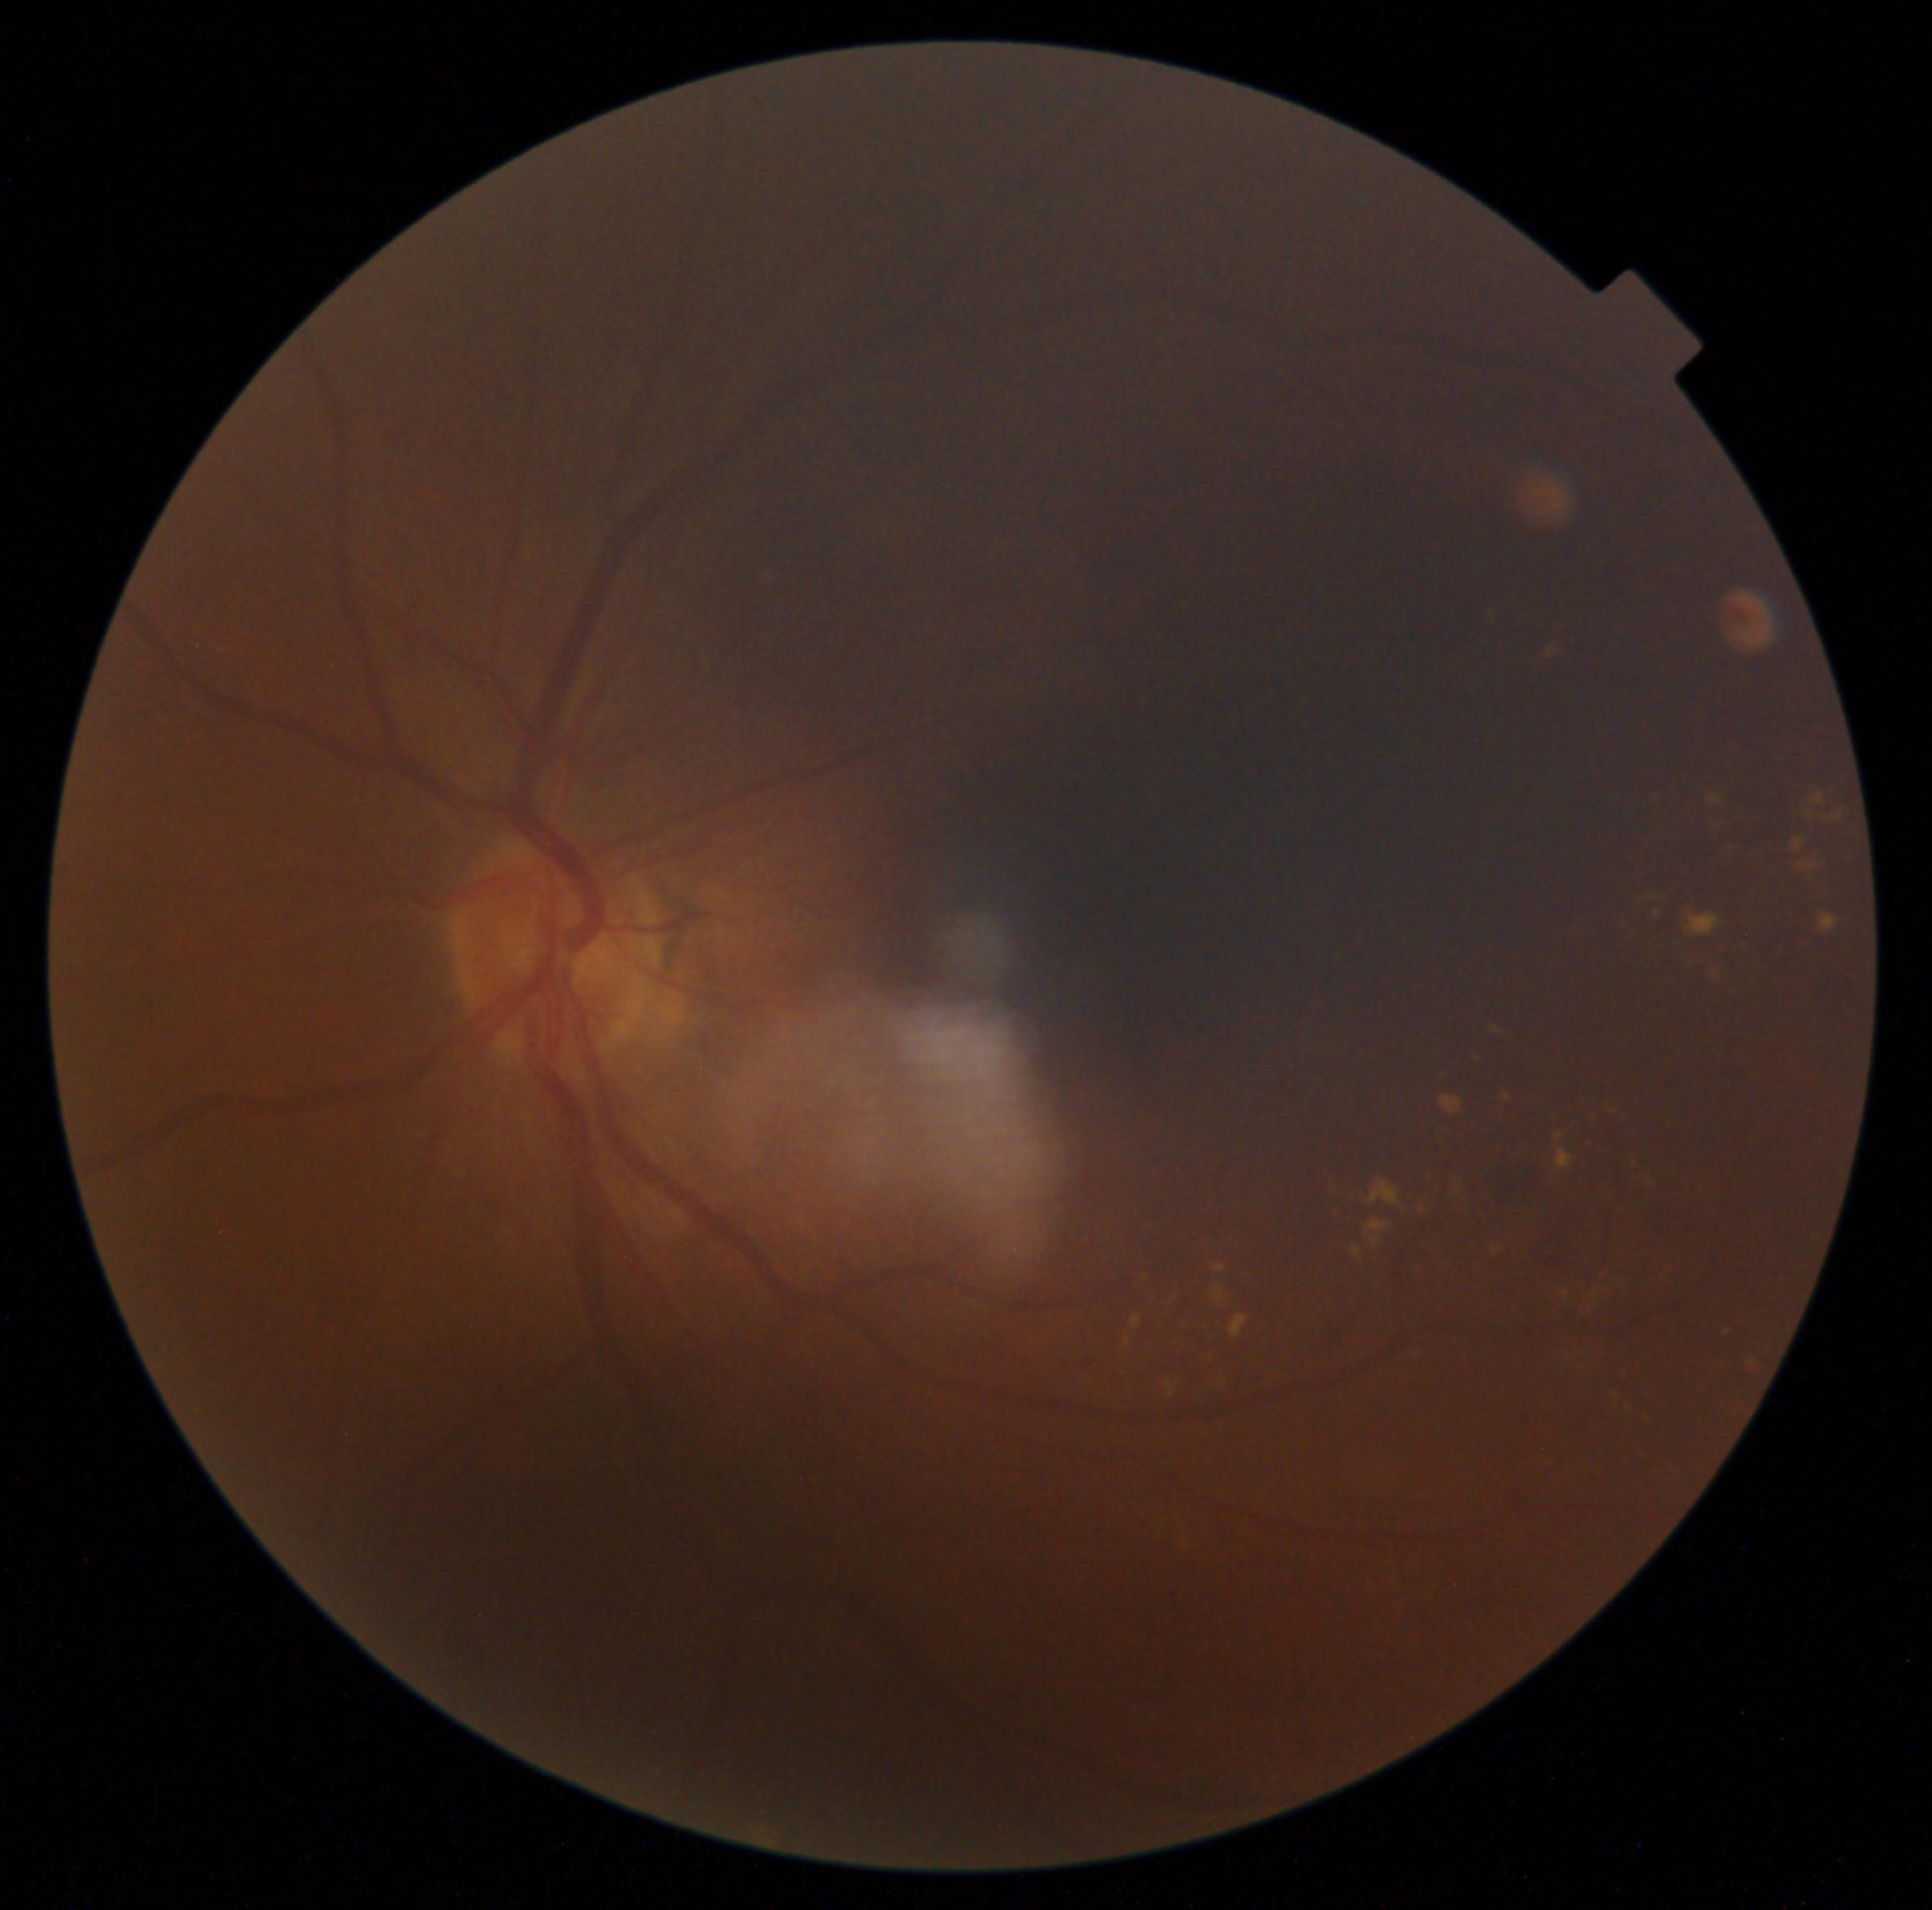
partial: true
dr_grade: 2
dr_grade_name: moderate NPDR
lesions:
  ex:
    - x1=1644, y1=1176, x2=1656, y2=1191
    - x1=1372, y1=1237, x2=1381, y2=1248
    - x1=1557, y1=1150, x2=1574, y2=1169
    - x1=1793, y1=838, x2=1806, y2=852
    - x1=1821, y1=914, x2=1839, y2=931
    - x1=1601, y1=1097, x2=1625, y2=1123
    - x1=1449, y1=1176, x2=1465, y2=1202
    - x1=1546, y1=650, x2=1567, y2=675
    - x1=1443, y1=1266, x2=1454, y2=1286
    - x1=1621, y1=1368, x2=1630, y2=1376
    - x1=1178, y1=1321, x2=1189, y2=1338
    - x1=1472, y1=1057, x2=1481, y2=1071
    - x1=1687, y1=912, x2=1722, y2=936
    - x1=1712, y1=817, x2=1716, y2=838
    - x1=1414, y1=1266, x2=1421, y2=1286
    - x1=1212, y1=1290, x2=1223, y2=1304
    - x1=1654, y1=912, x2=1662, y2=918
  ex_small_centers:
    - pt(1508, 1098)